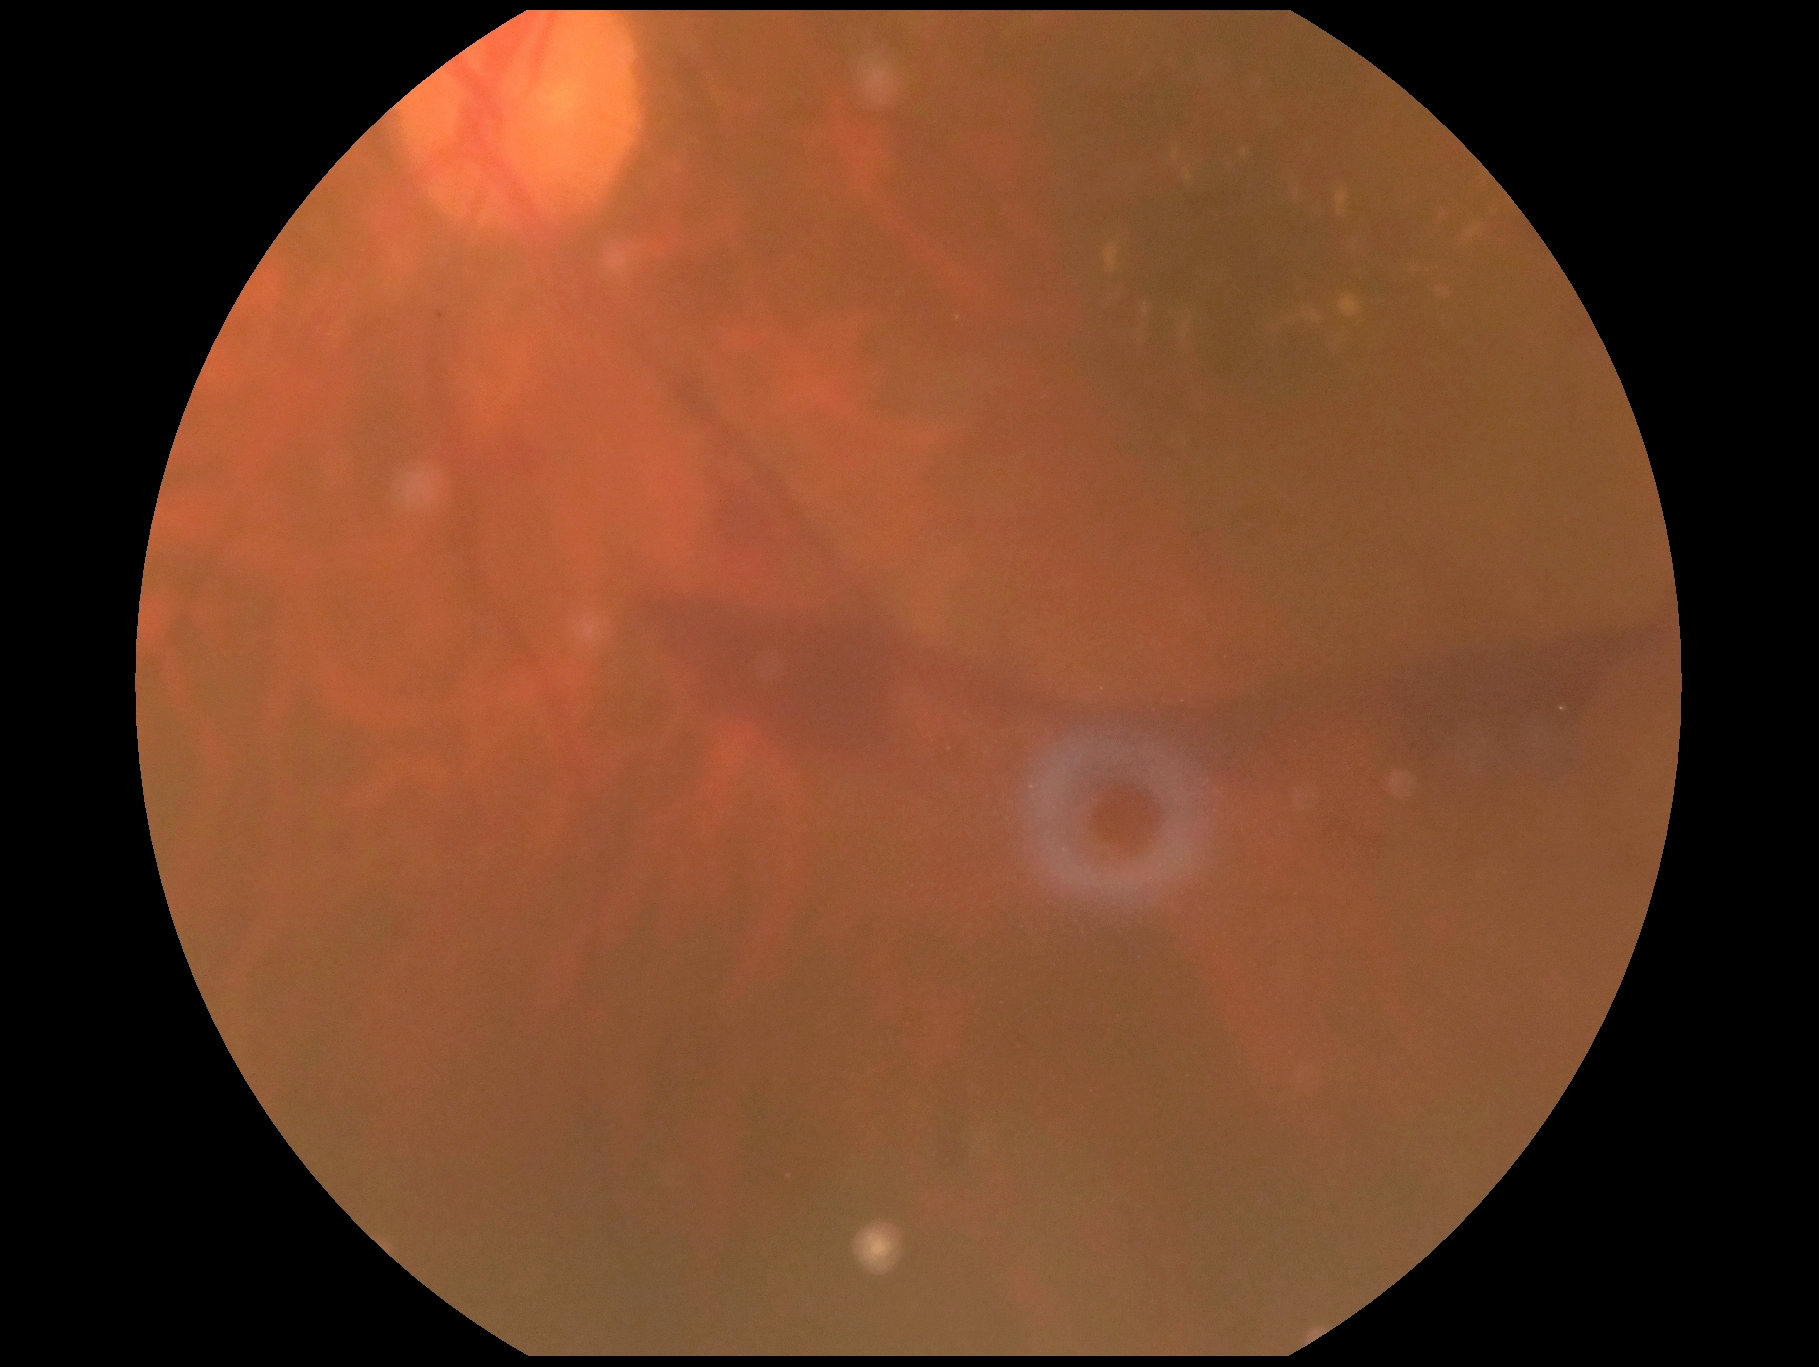 DR is PDR (grade 4).